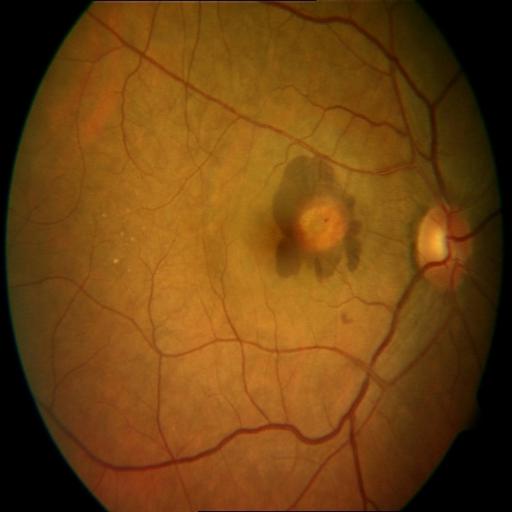
Diagnoses: chorioretinitis (CRS).